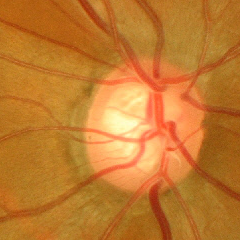 Impression: severe glaucomatous damage.